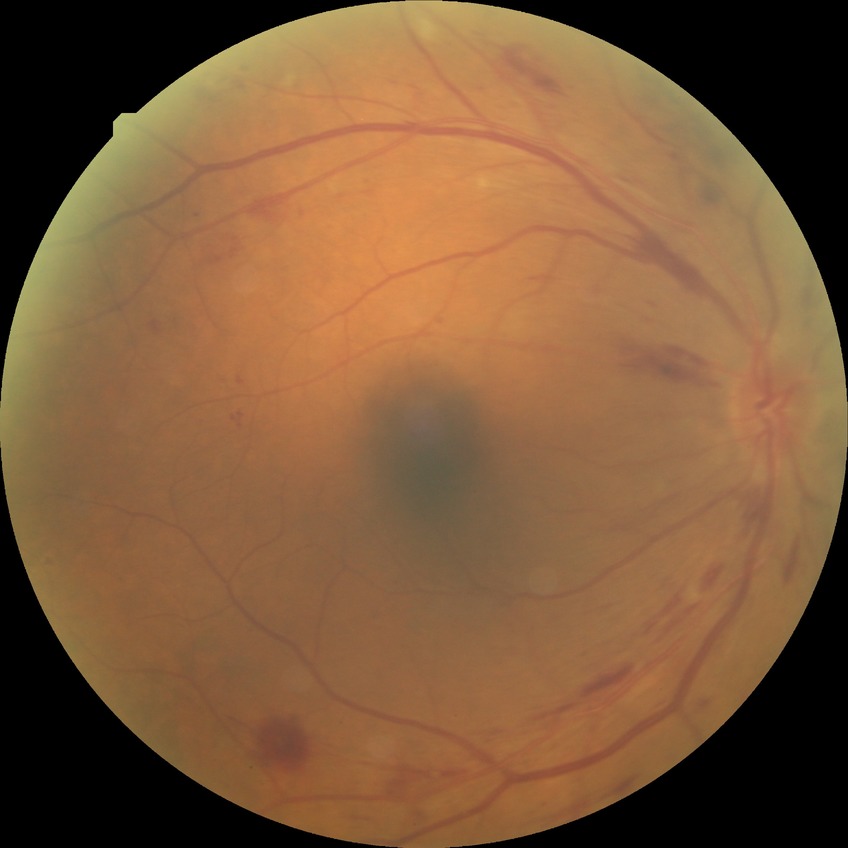

DR severity is PPDR.